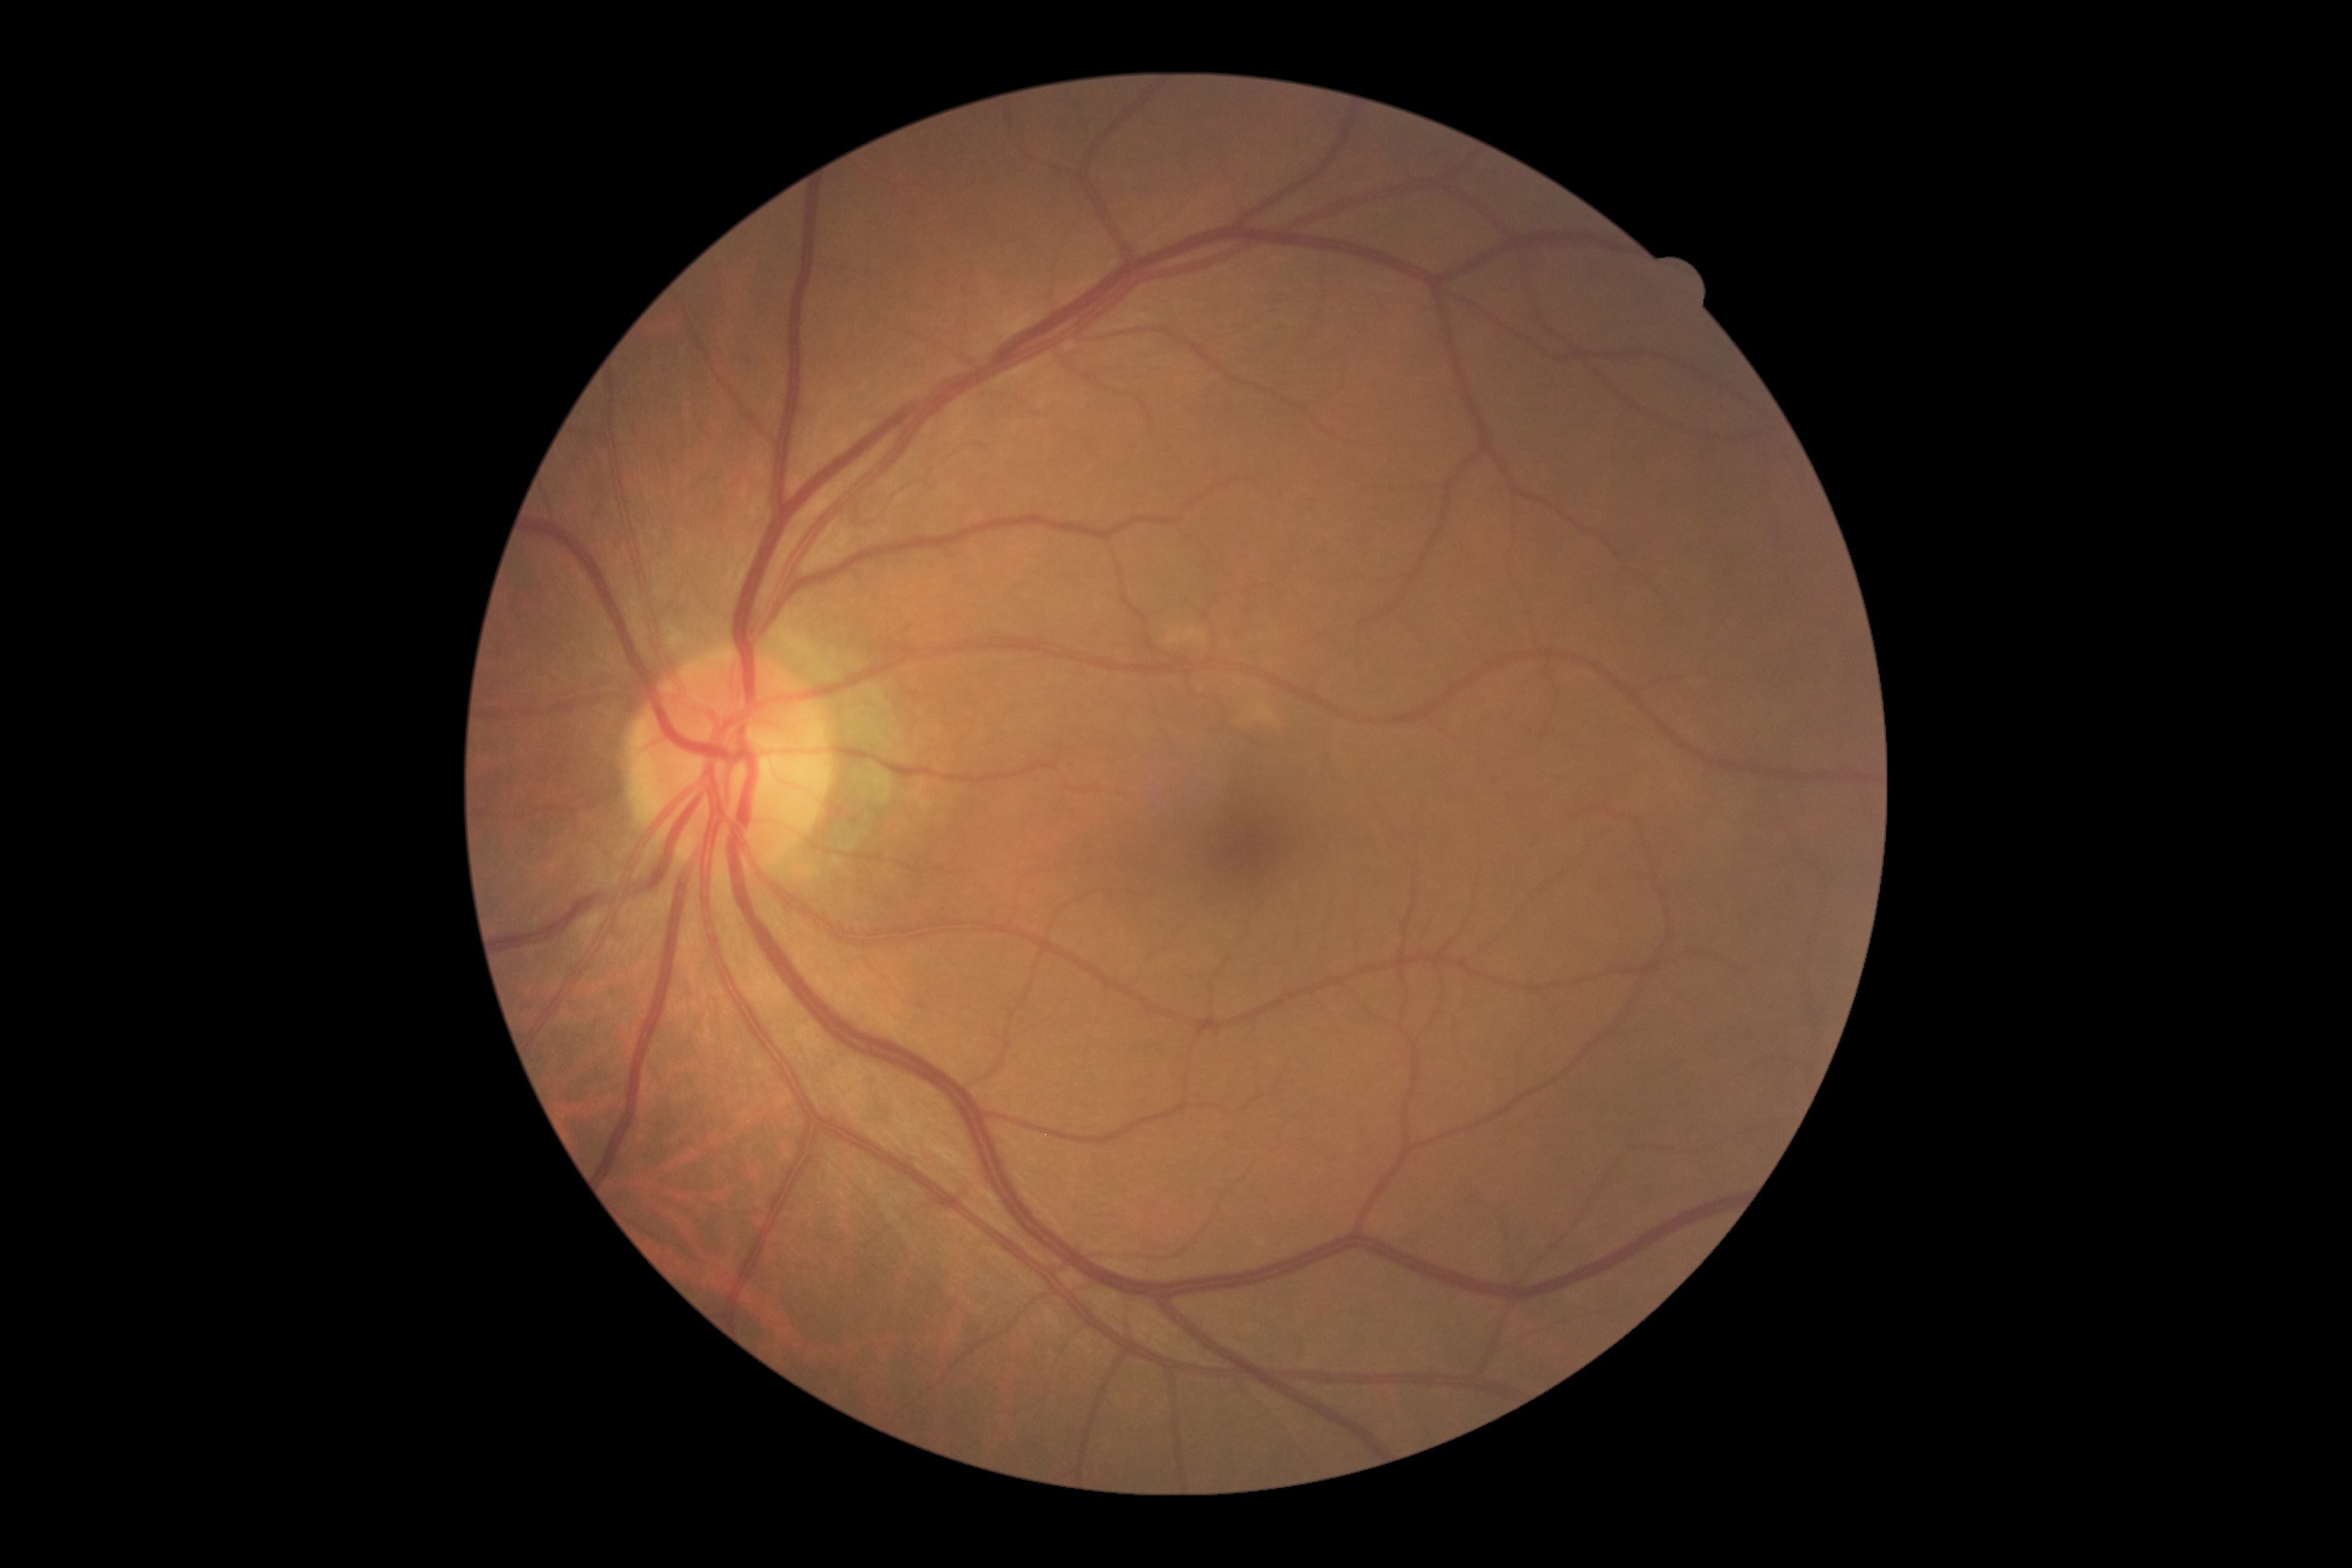

Diabetic retinopathy is 0.